Fundus photo
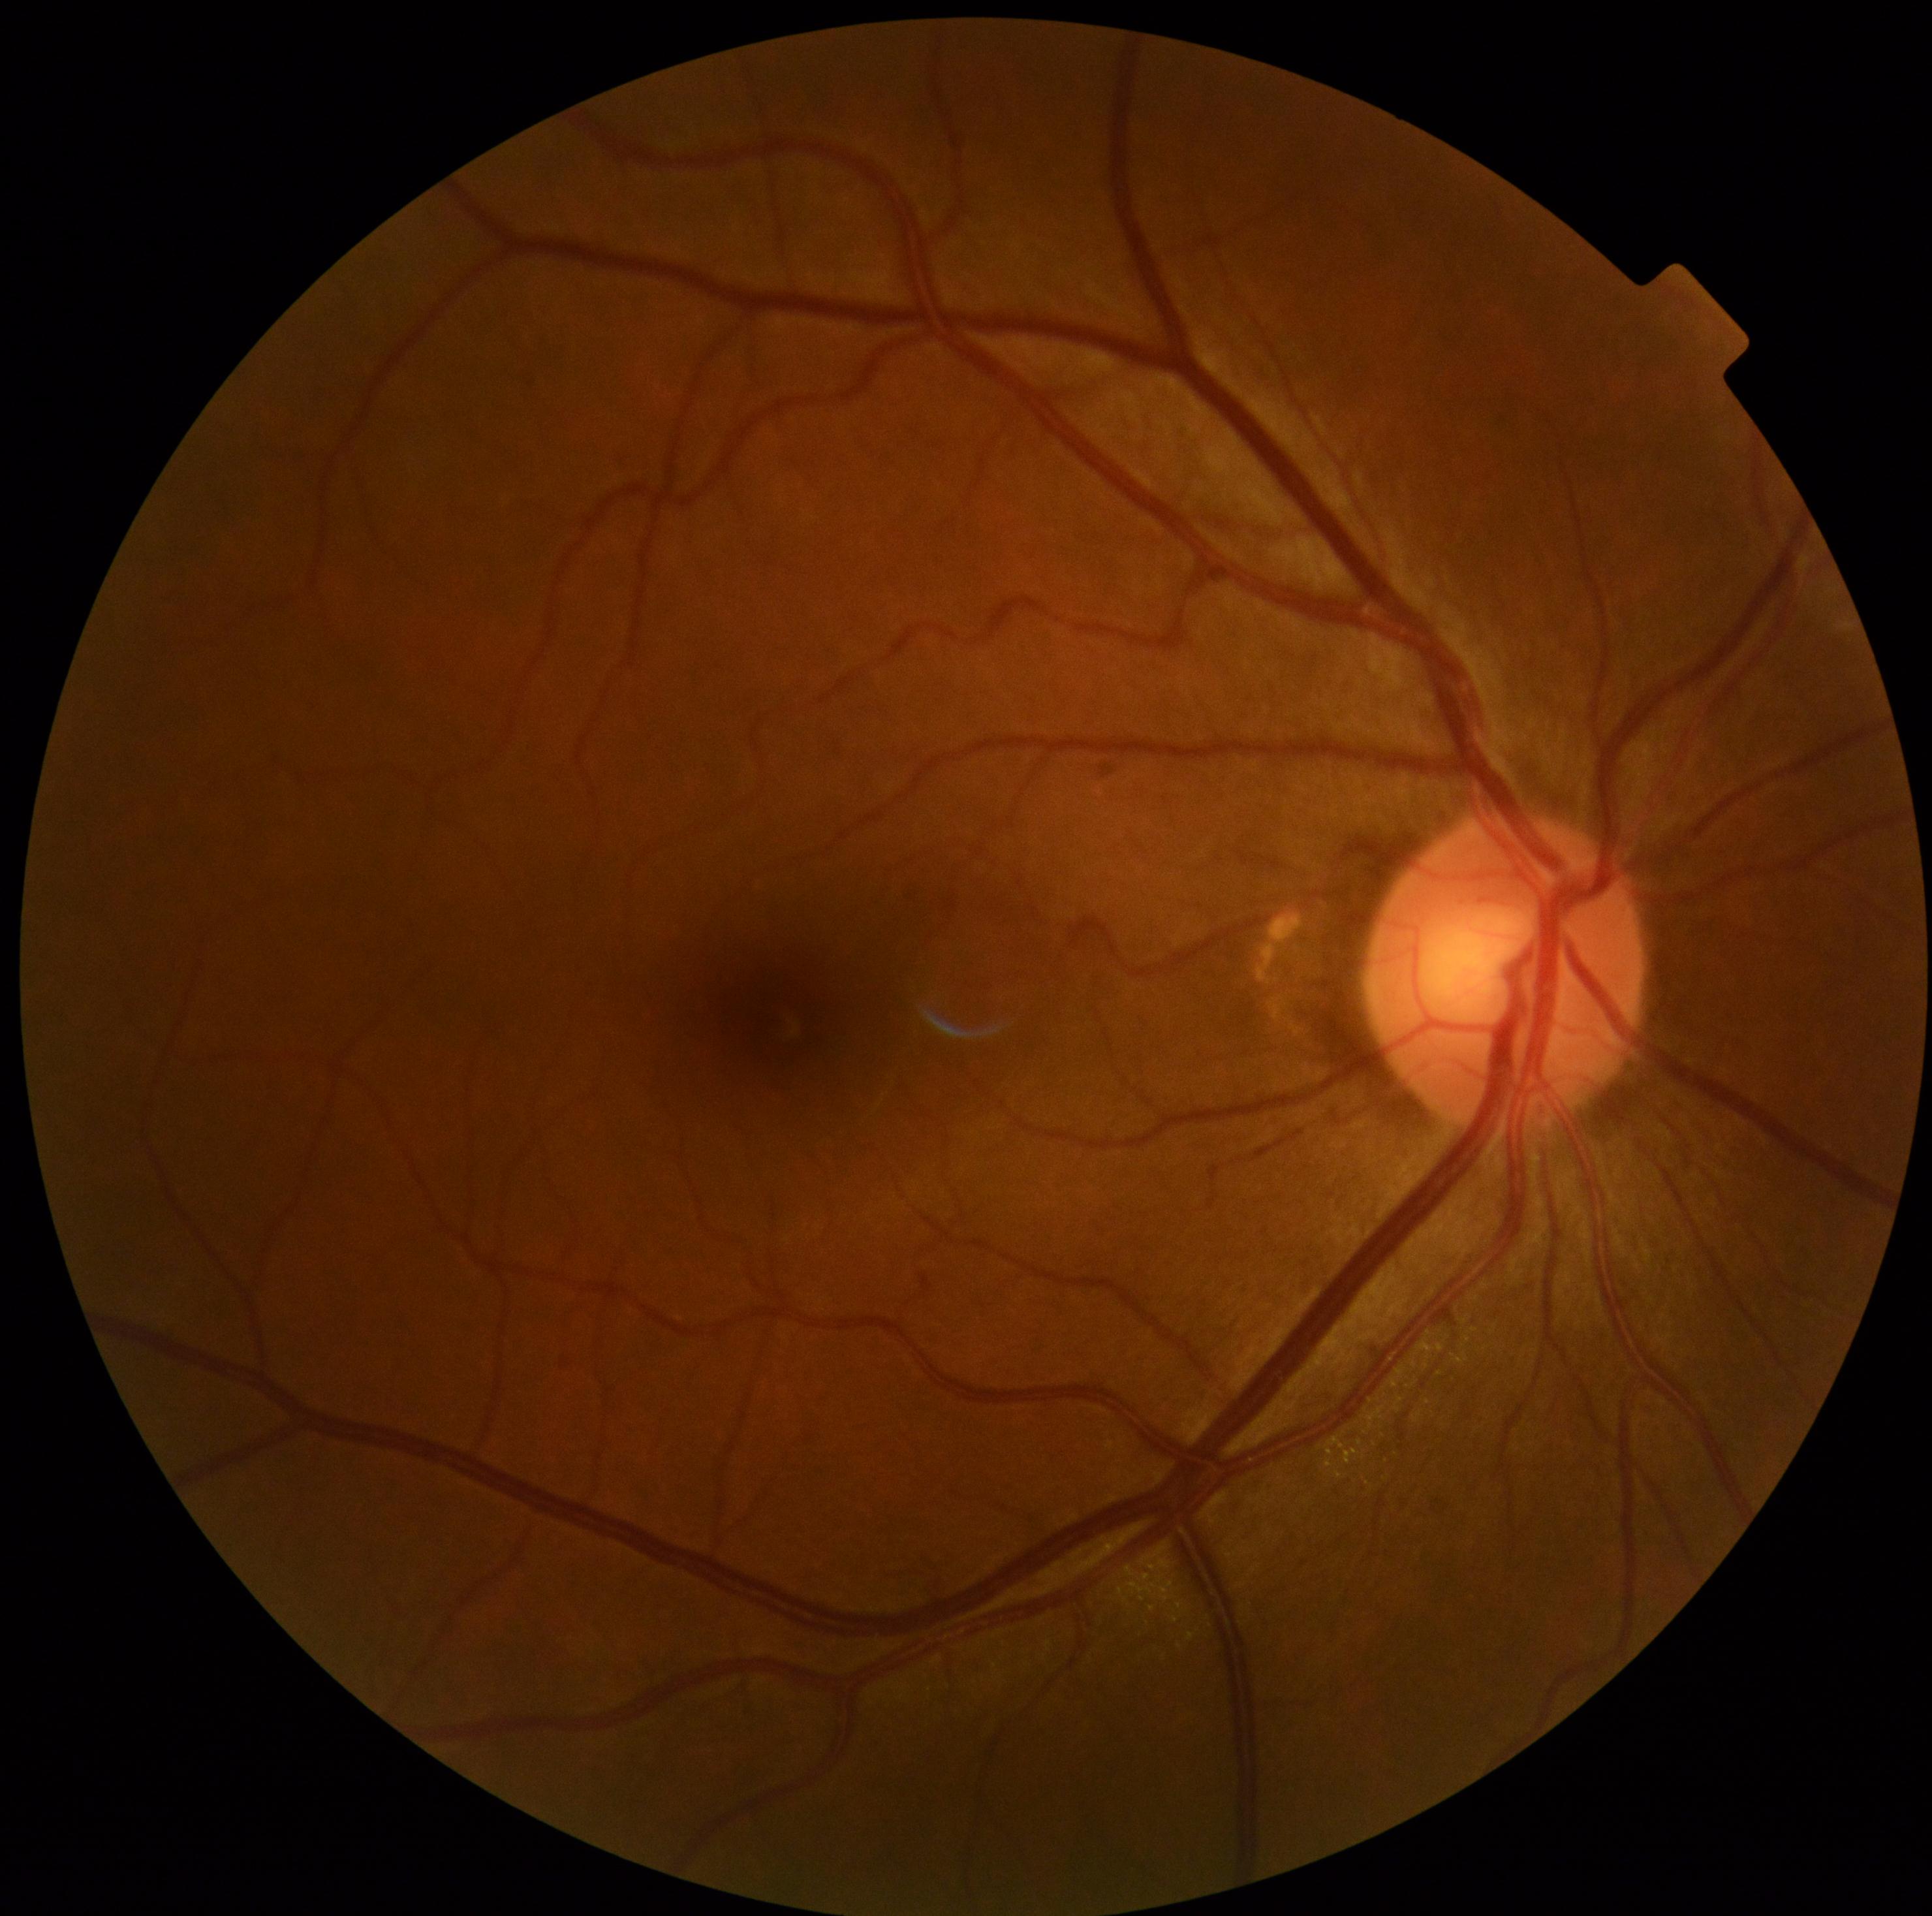
No signs of diabetic retinopathy. DR stage: no apparent retinopathy (grade 0).